Camera: NIDEK AFC-230
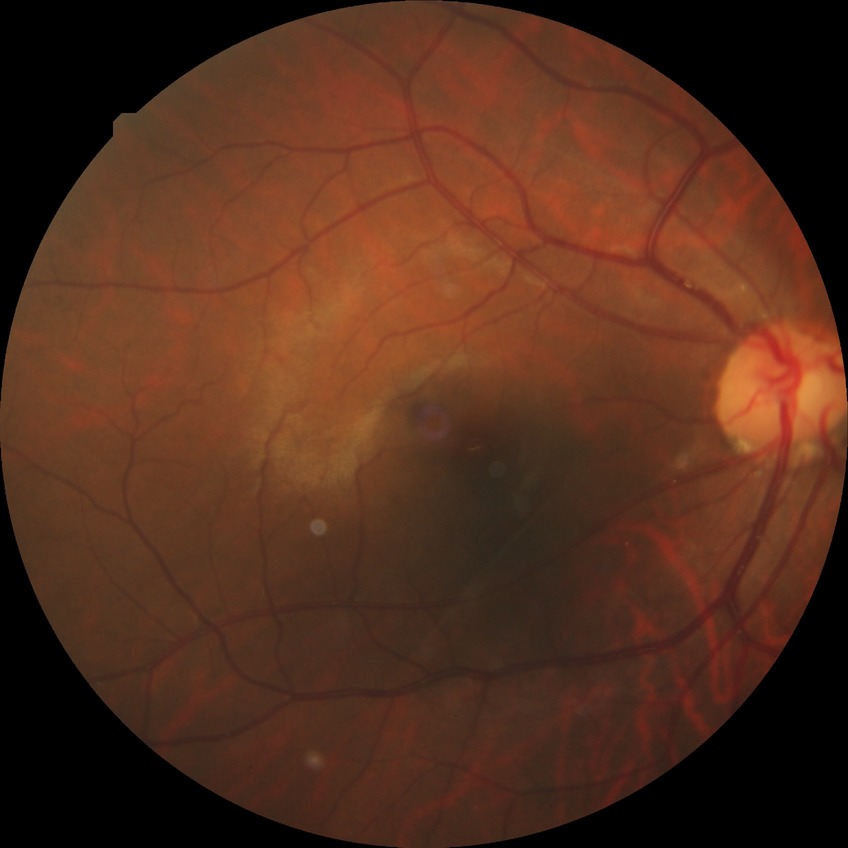
Retinopathy stage: no diabetic retinopathy.